848 x 848 pixels, without pupil dilation, 45-degree field of view.
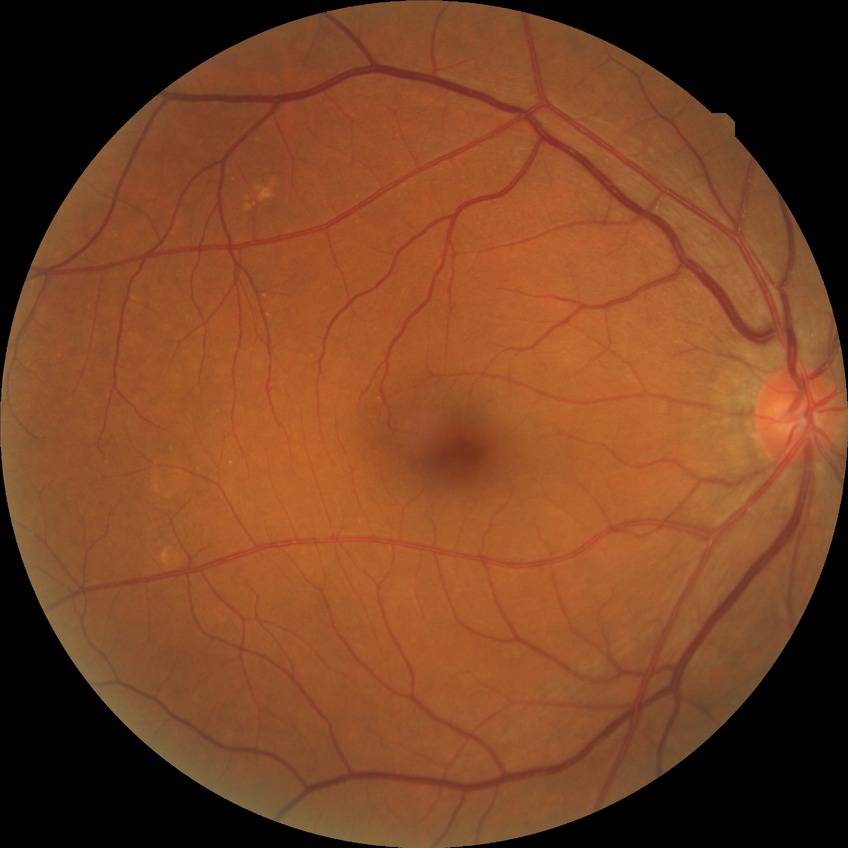

diabetic retinopathy (DR)@NDR (no diabetic retinopathy).